No pharmacologic dilation · NIDEK AFC-230 fundus camera · fundus photo · FOV: 45 degrees · 848 by 848 pixels
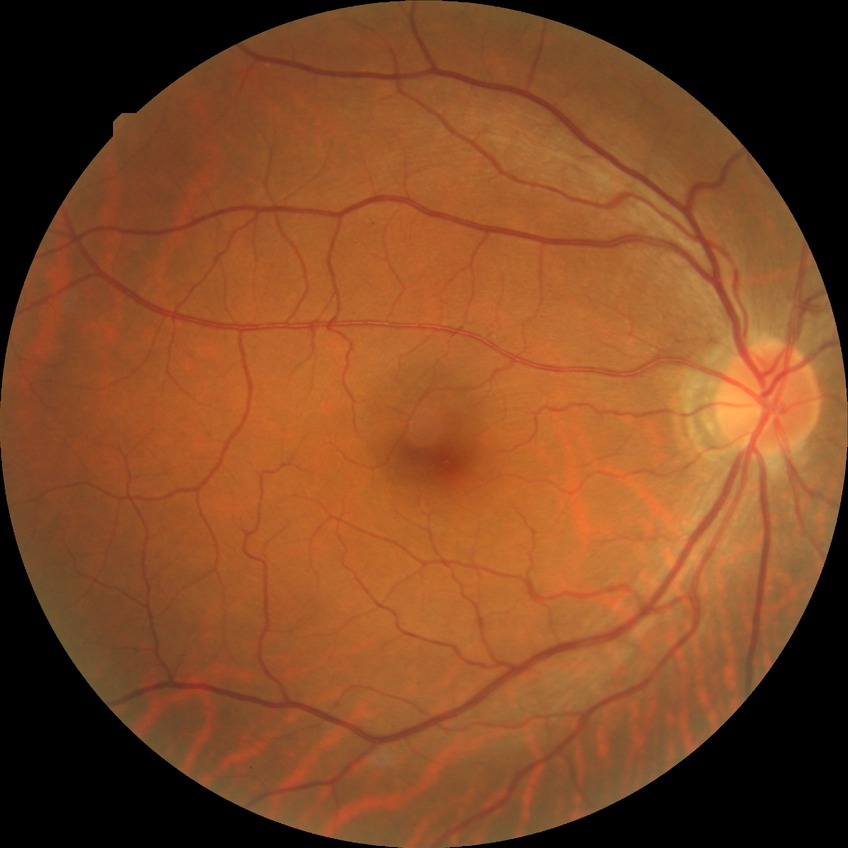

Retinopathy grade: no diabetic retinopathy.